45° field of view, 2352 x 1568 pixels.
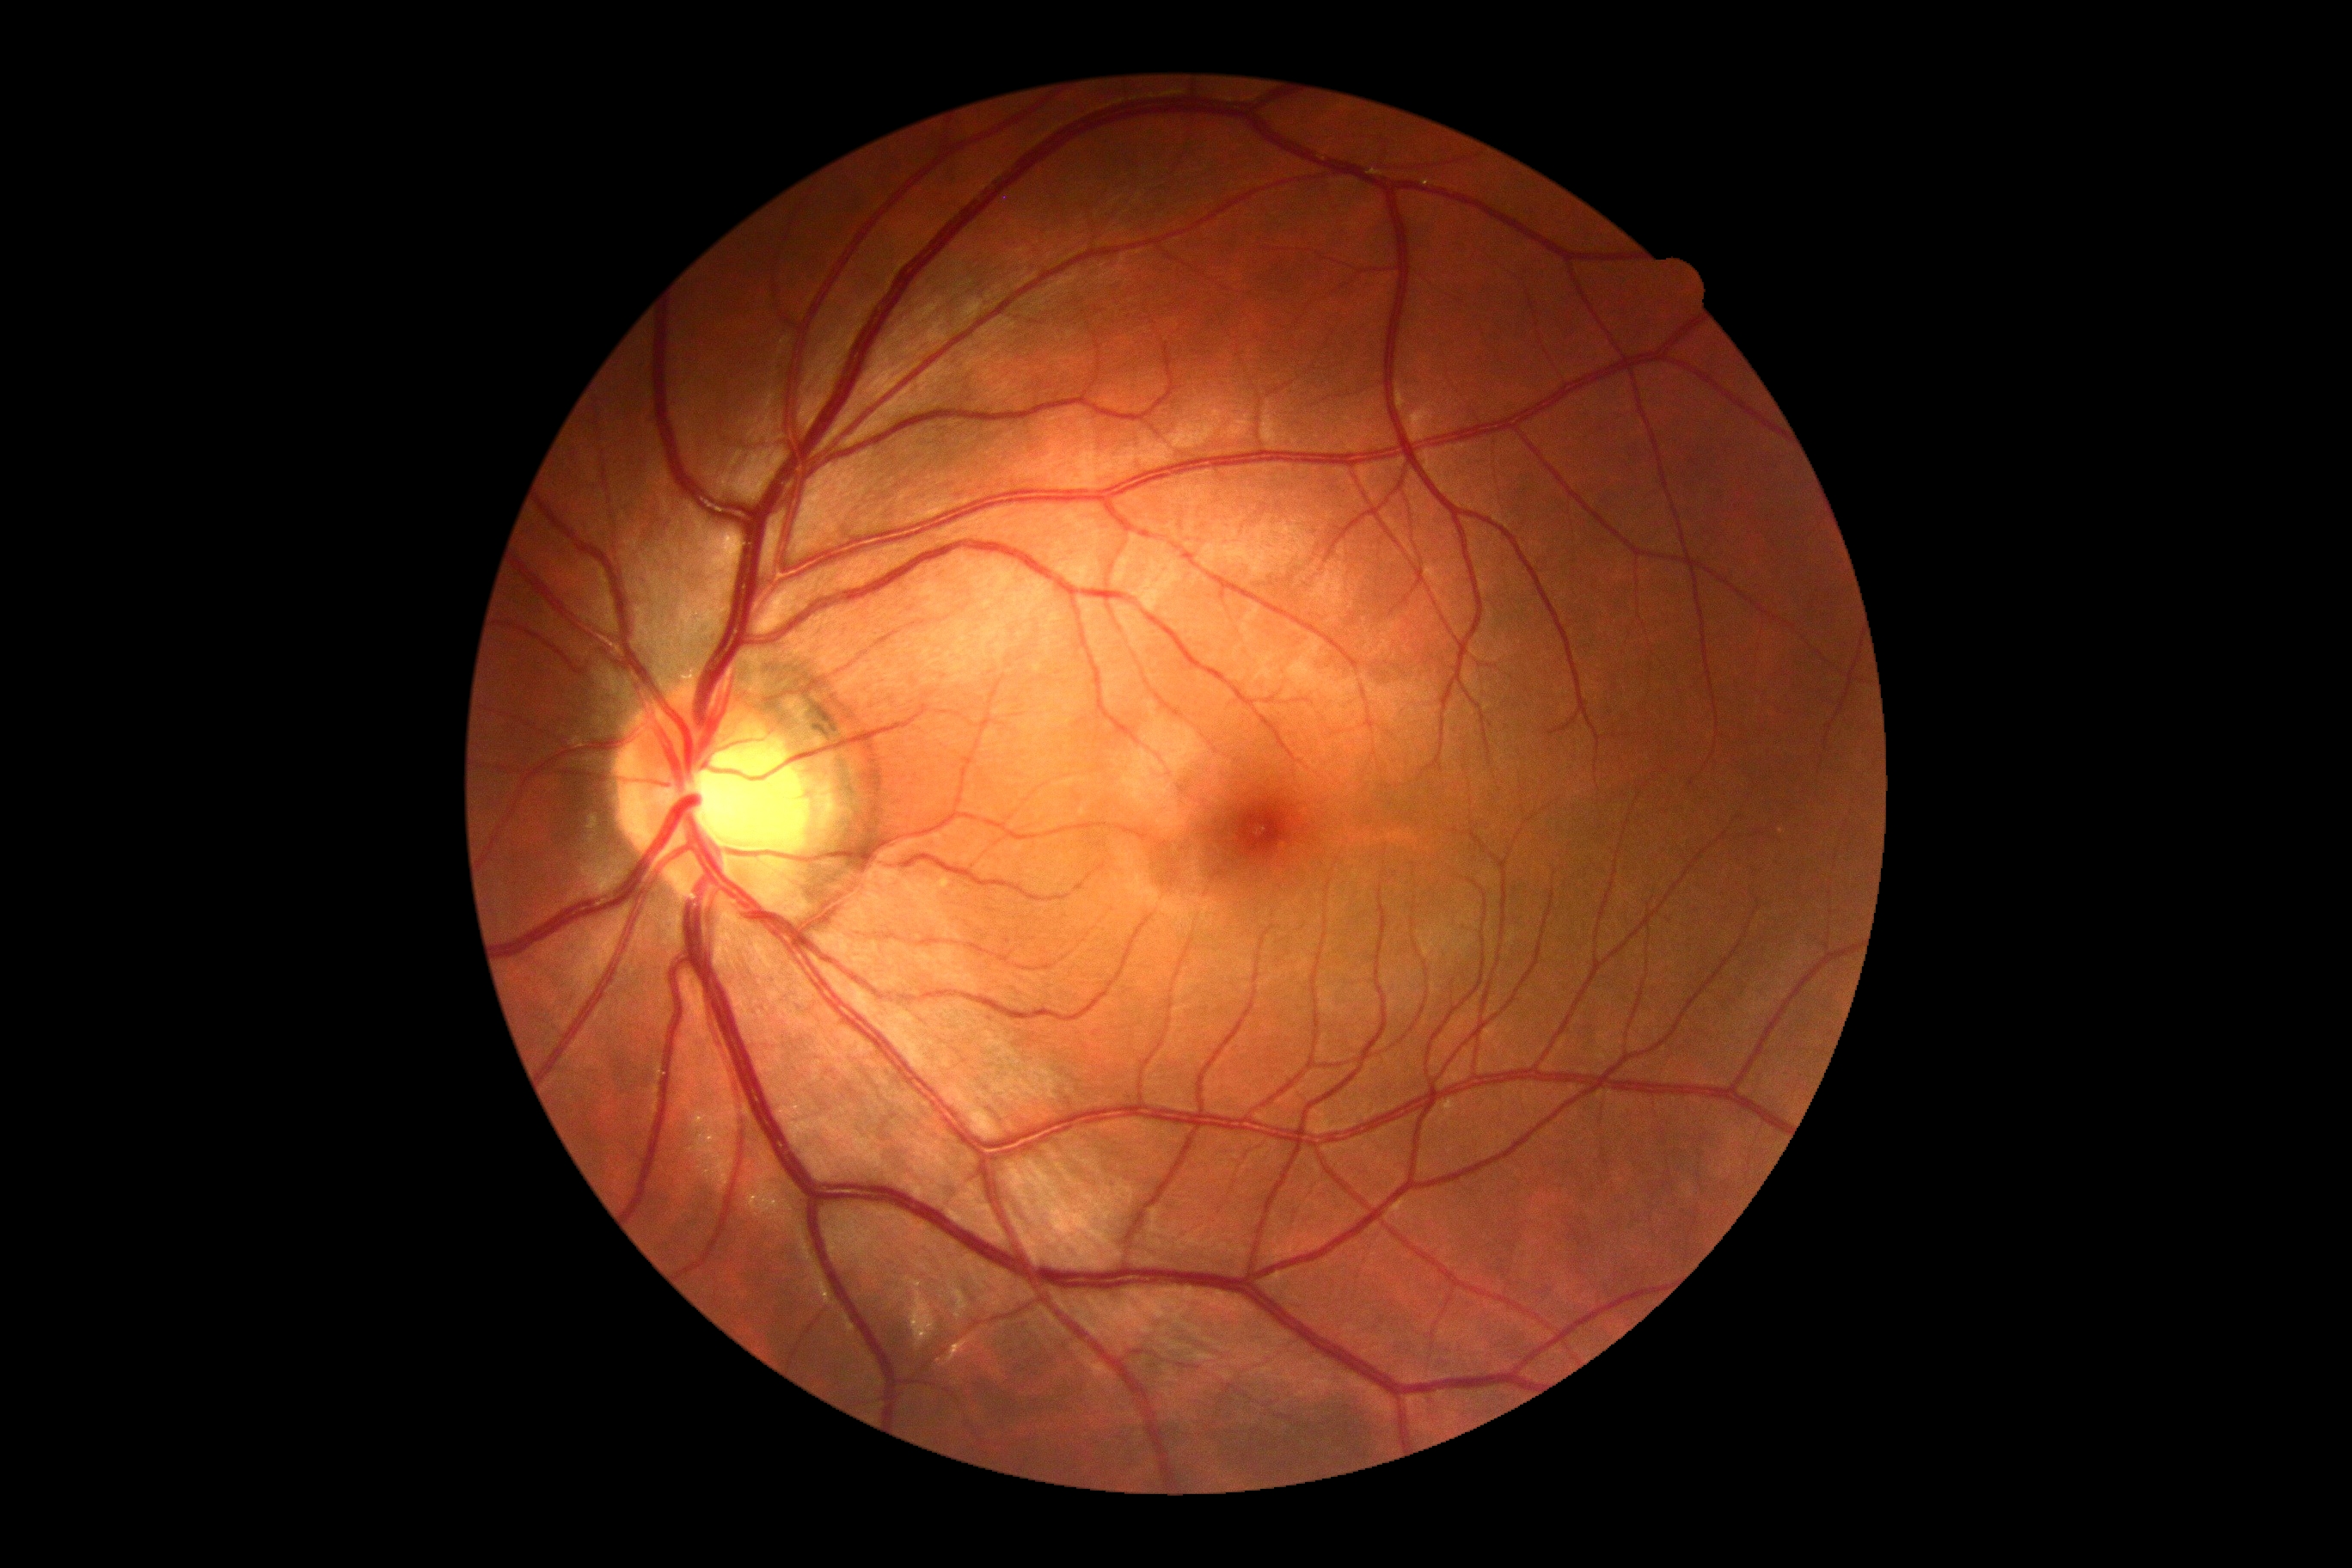 DR impression: no signs of DR; diabetic retinopathy (DR): 0/4.